Image size 1440x1080. Wide-field fundus photograph from neonatal ROP screening:
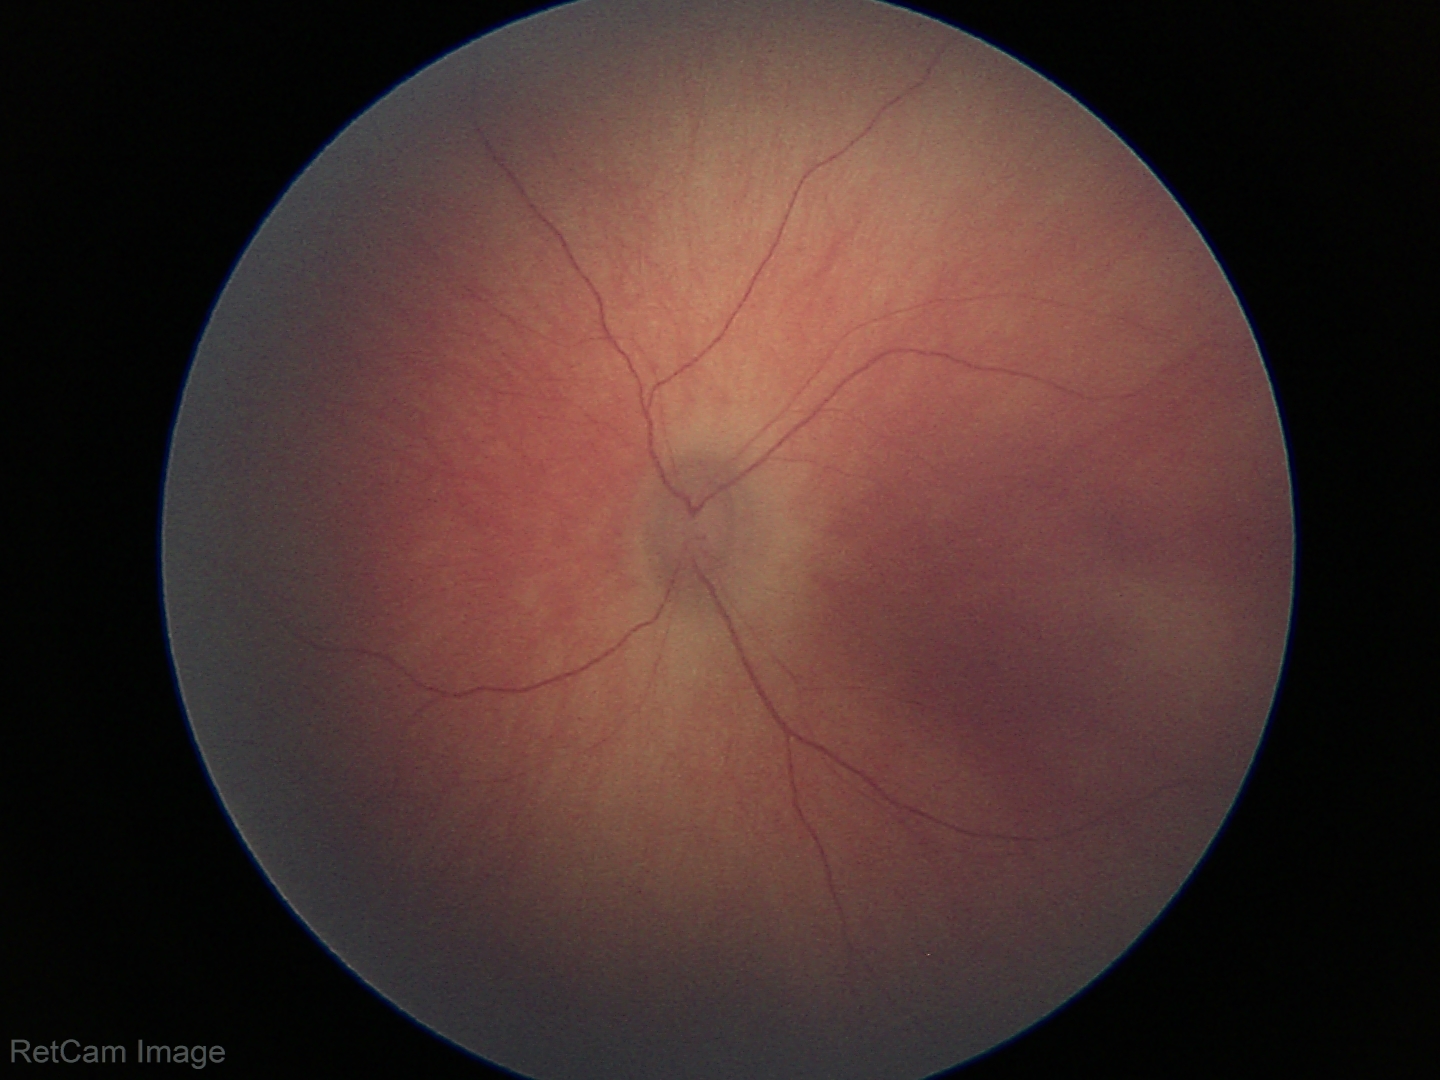

Impression: physiological retinal finding.